45° FOV: 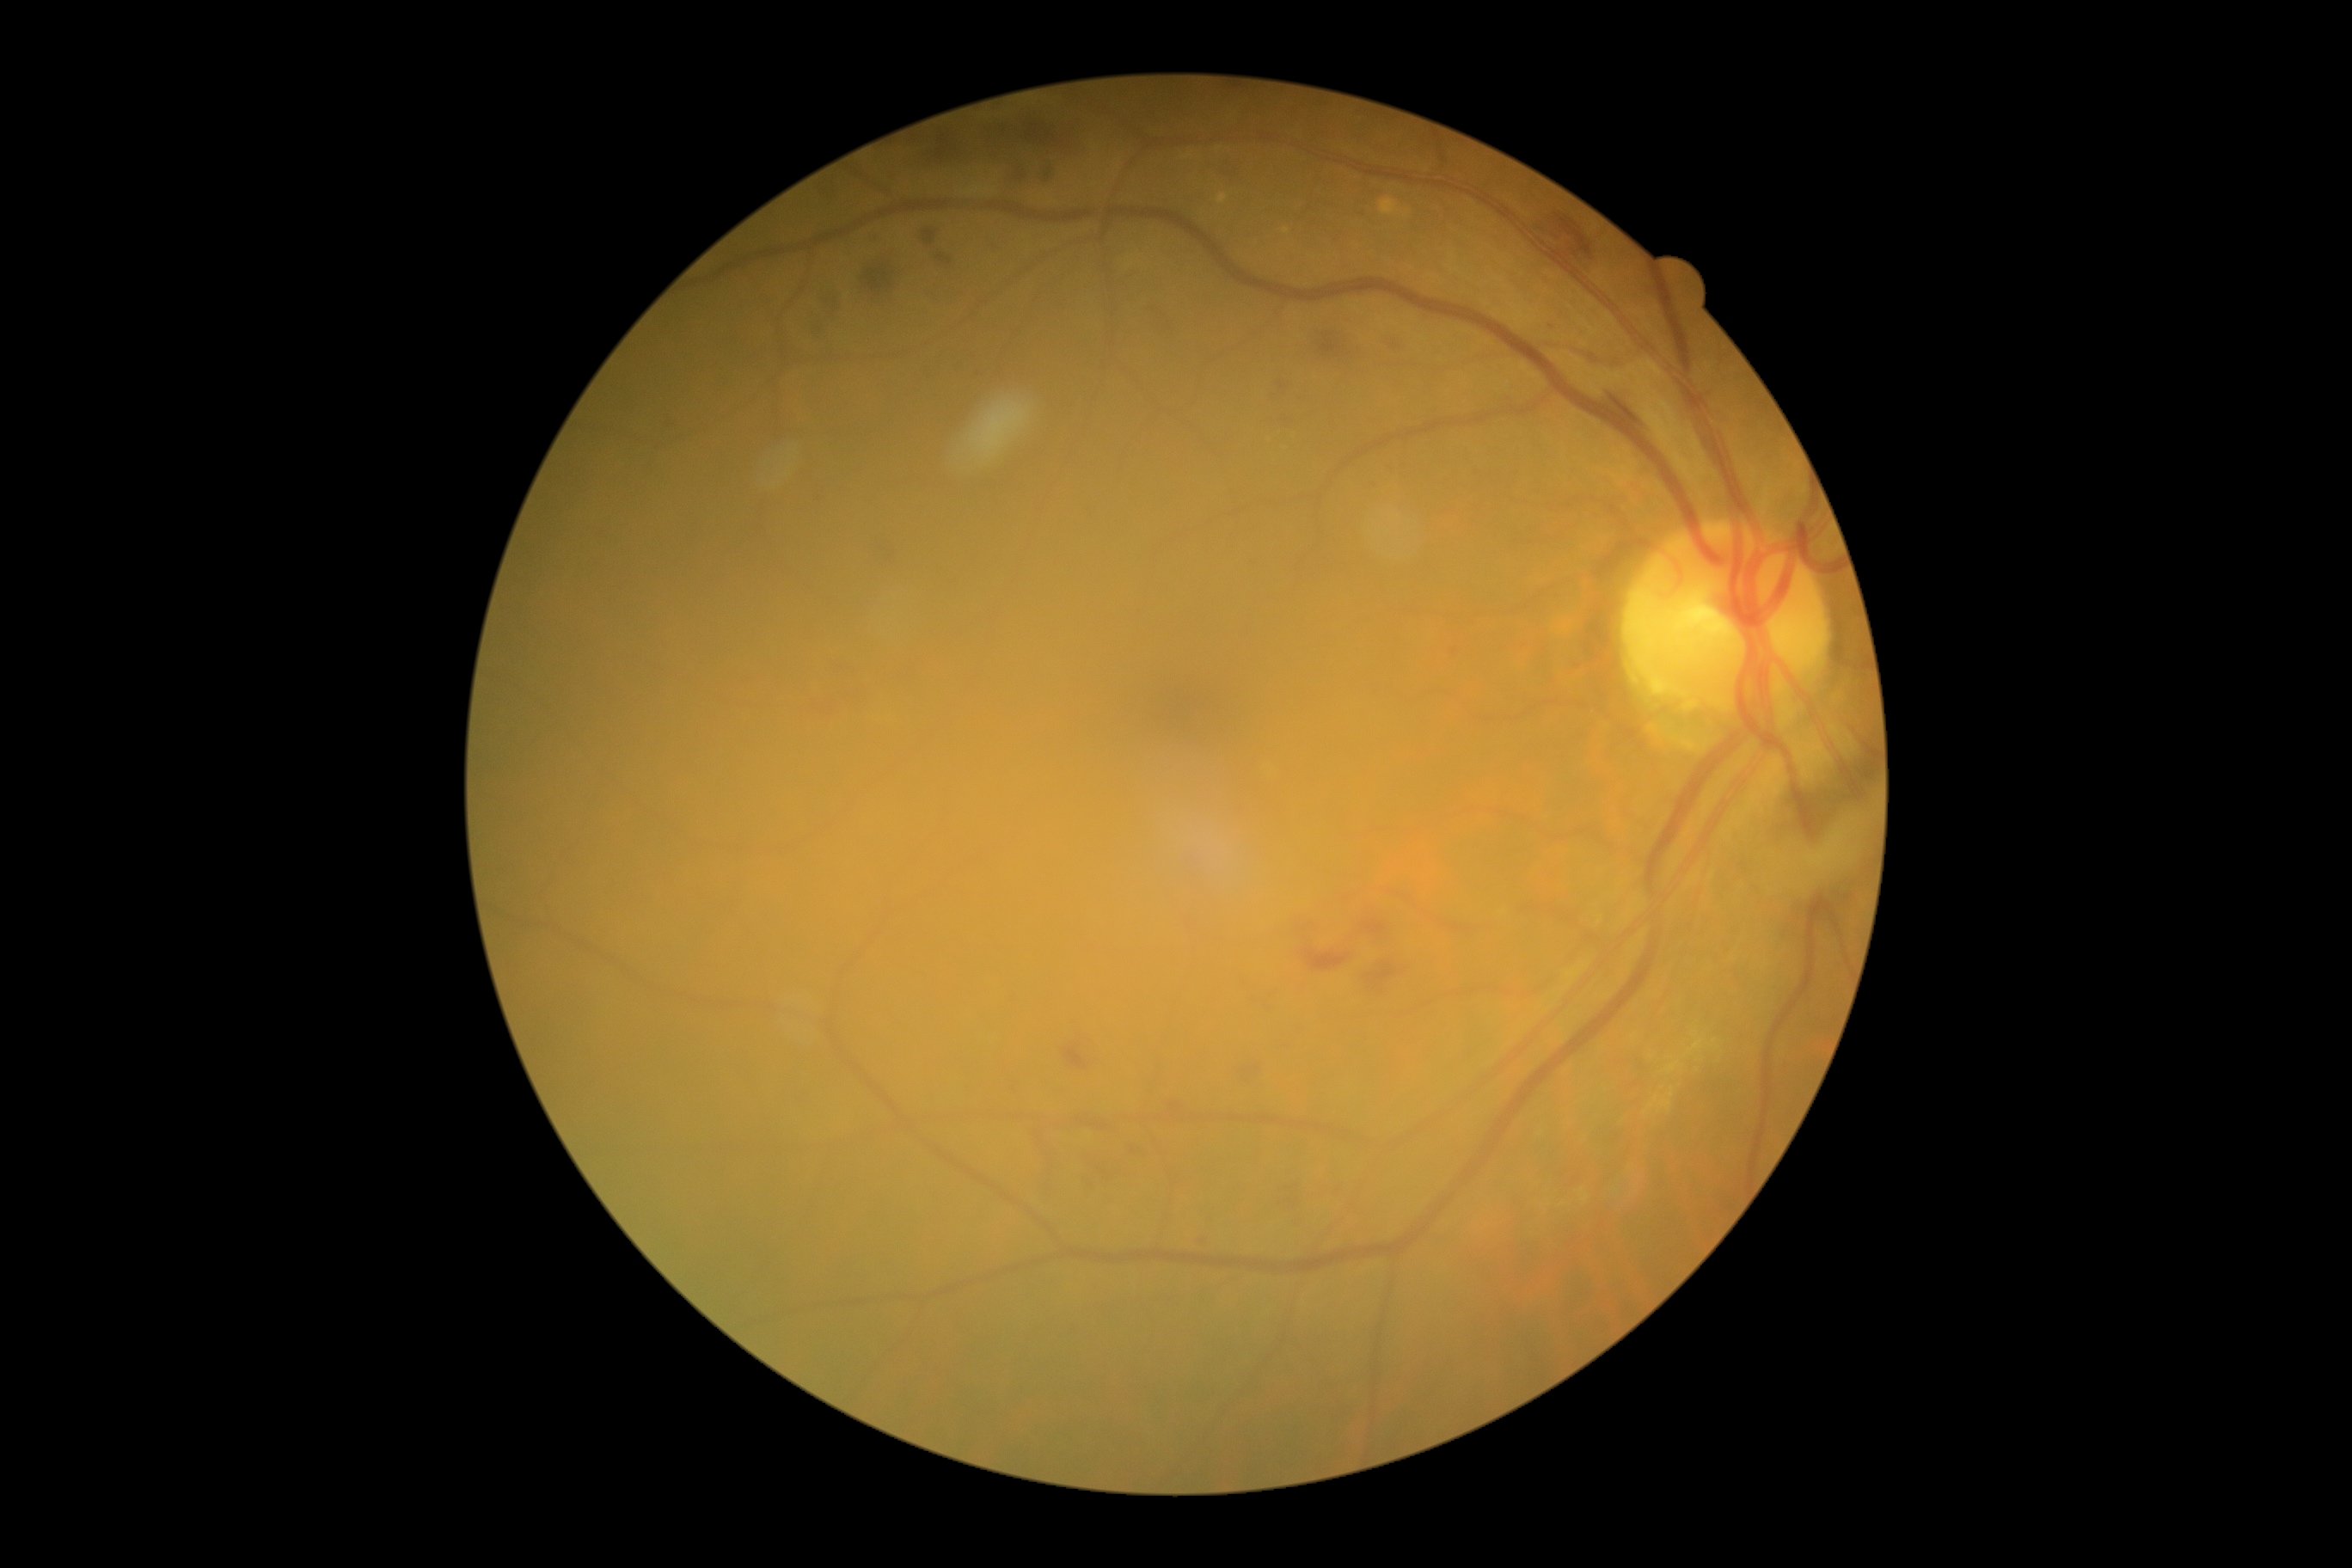

Retinopathy grade is 2 (moderate NPDR)
A subset of detected lesions:
- hemorrhages (partial): (left=800, top=687, right=871, bottom=721), (left=1538, top=205, right=1598, bottom=273), (left=955, top=364, right=964, bottom=374), (left=1058, top=1031, right=1098, bottom=1074), (left=818, top=181, right=838, bottom=202), (left=1082, top=1153, right=1125, bottom=1184), (left=928, top=290, right=941, bottom=303), (left=1146, top=305, right=1177, bottom=336), (left=1043, top=161, right=1055, bottom=185), (left=971, top=353, right=977, bottom=362), (left=1163, top=1099, right=1189, bottom=1113), (left=1270, top=379, right=1292, bottom=401), (left=1220, top=162, right=1244, bottom=187)